Davis DR grading · FOV: 45 degrees.
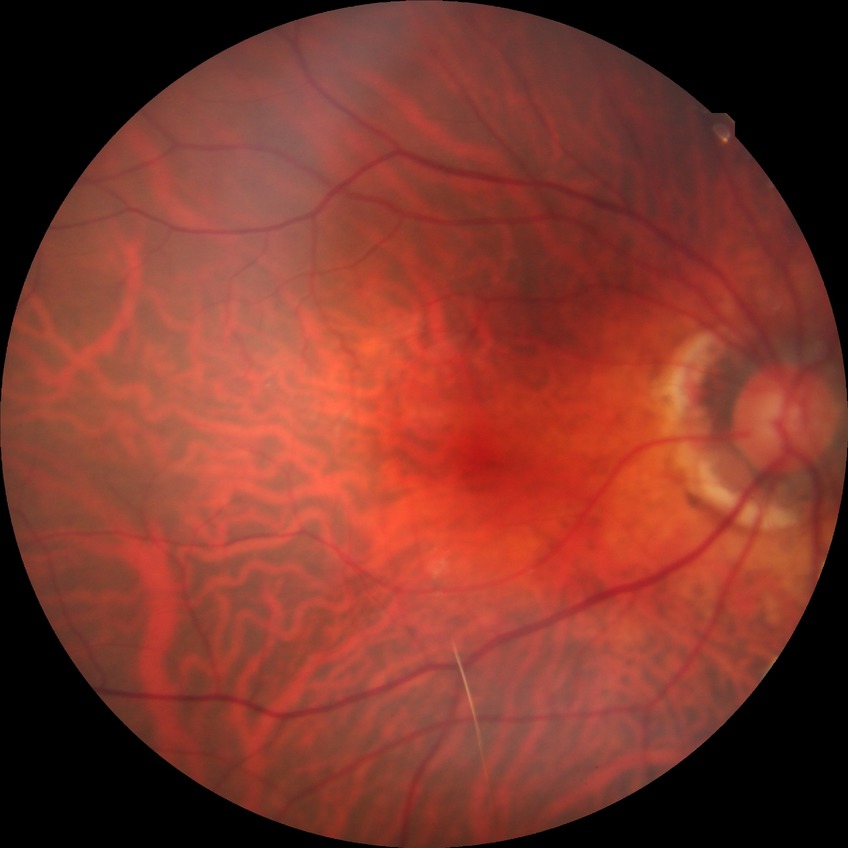 Diabetic retinopathy severity is no diabetic retinopathy.